Color fundus photograph, 1659 x 2212 pixels:
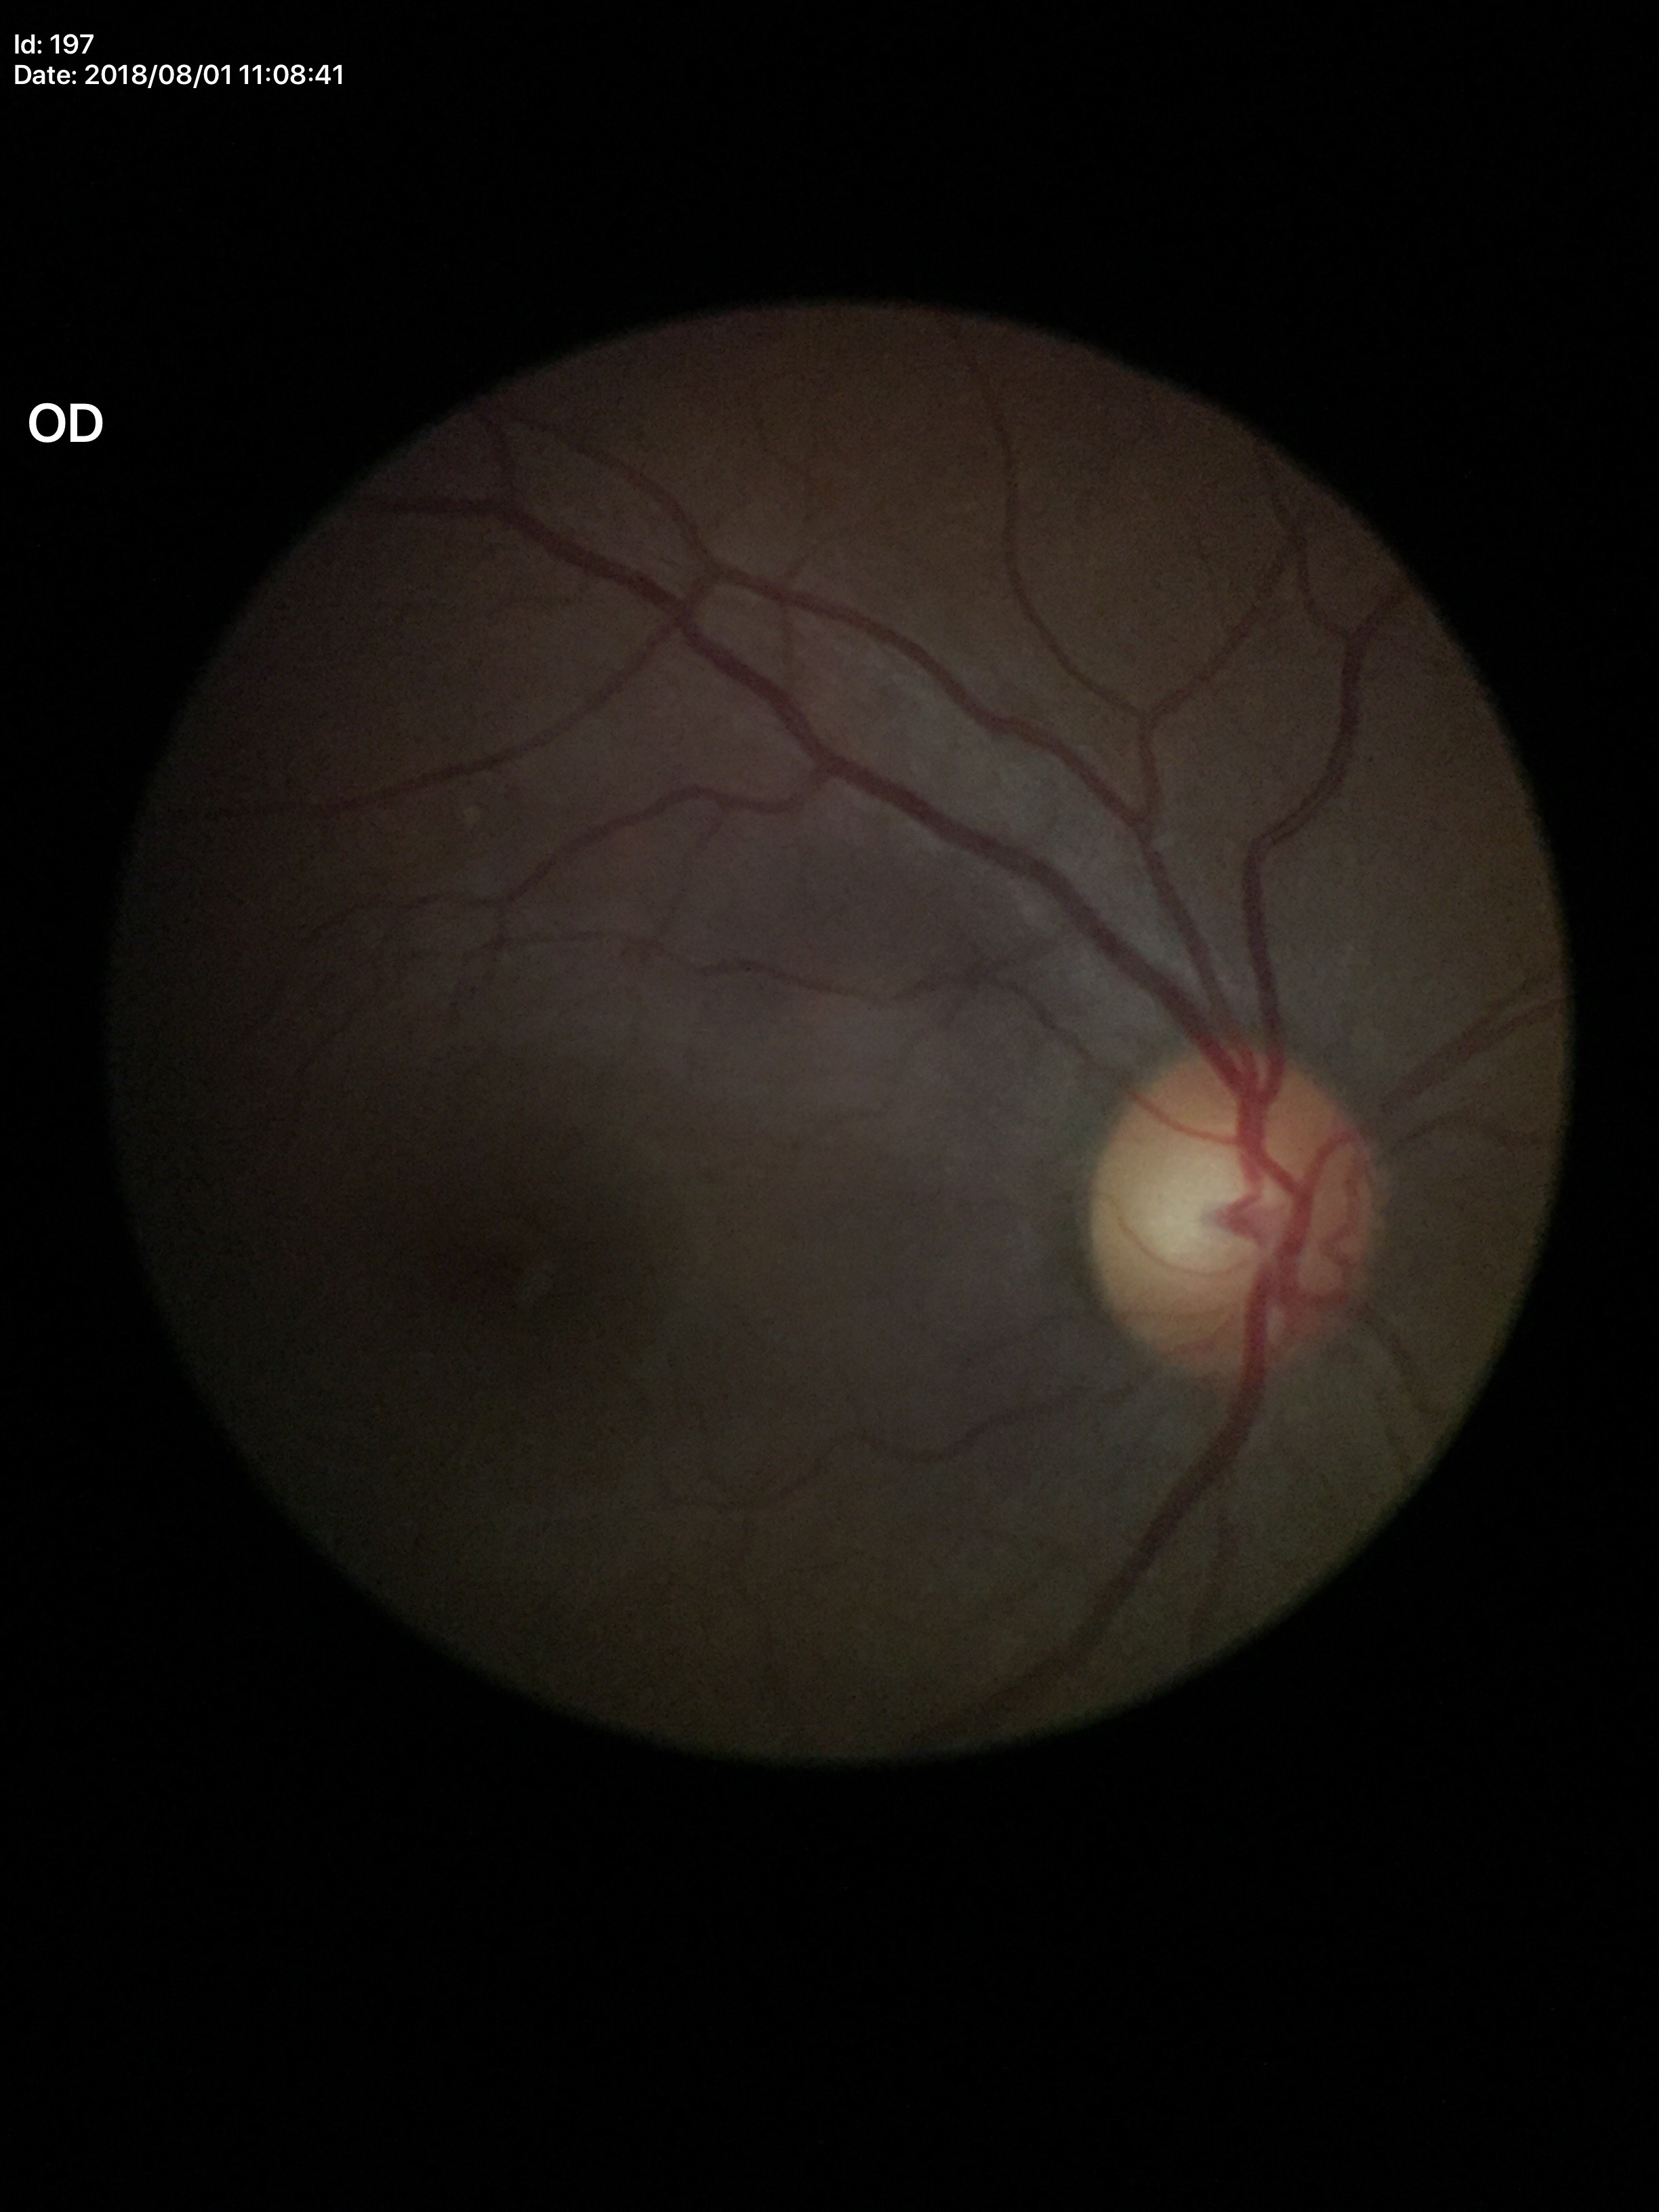

No glaucomatous findings (2 of 5 graders flagged glaucoma suspect). Vertical C/D ratio is 0.57.